848x848px; nonmydriatic; fundus photo:
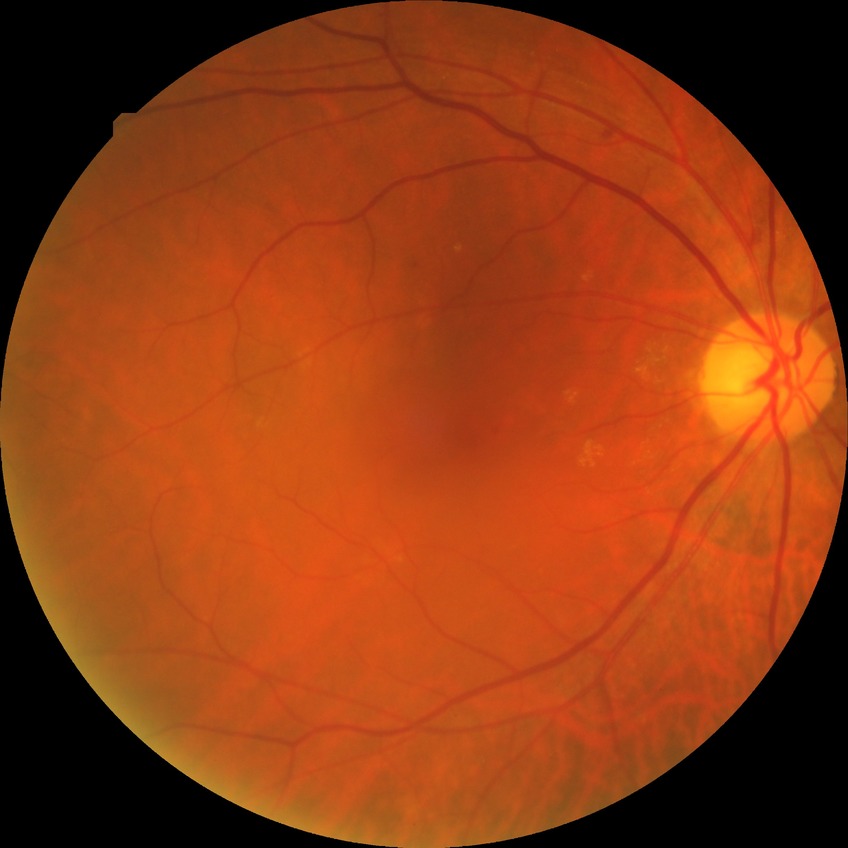 DR: SDR. The retinopathy is classified as non-proliferative diabetic retinopathy.